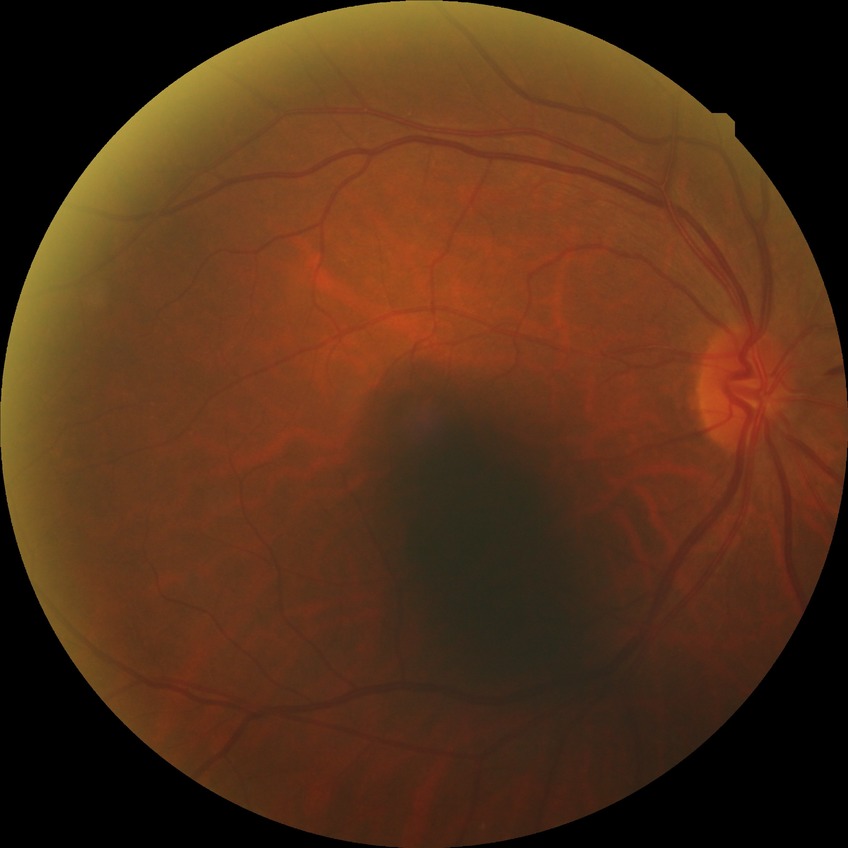

  davis_grade: no diabetic retinopathy